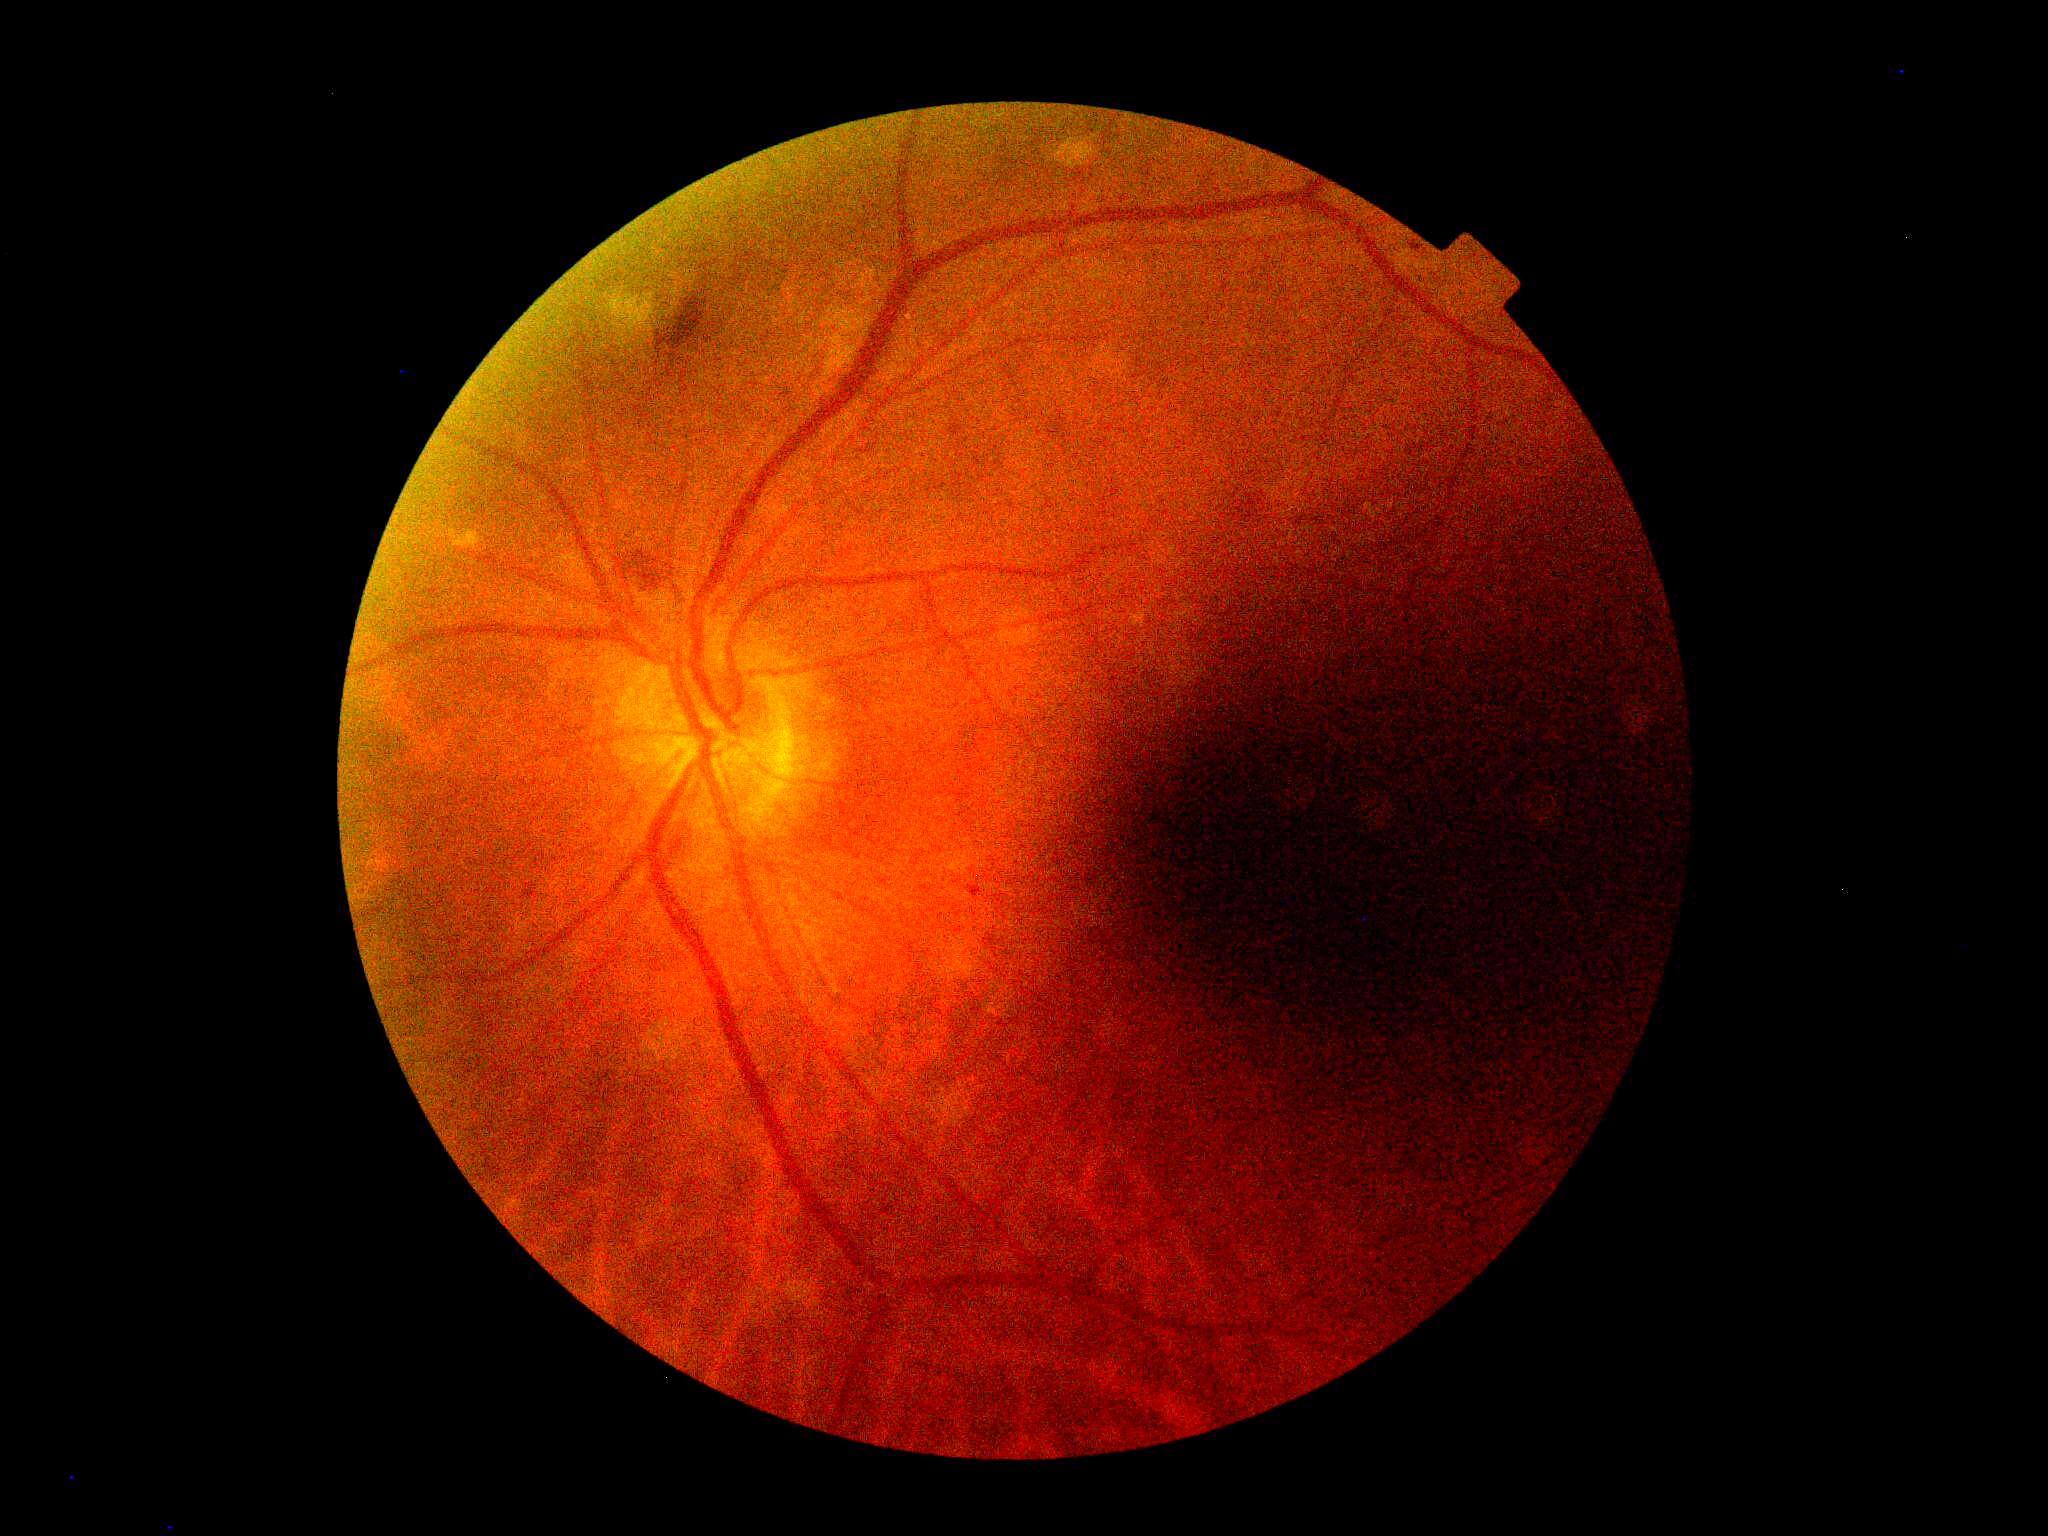
DR stage is 2.